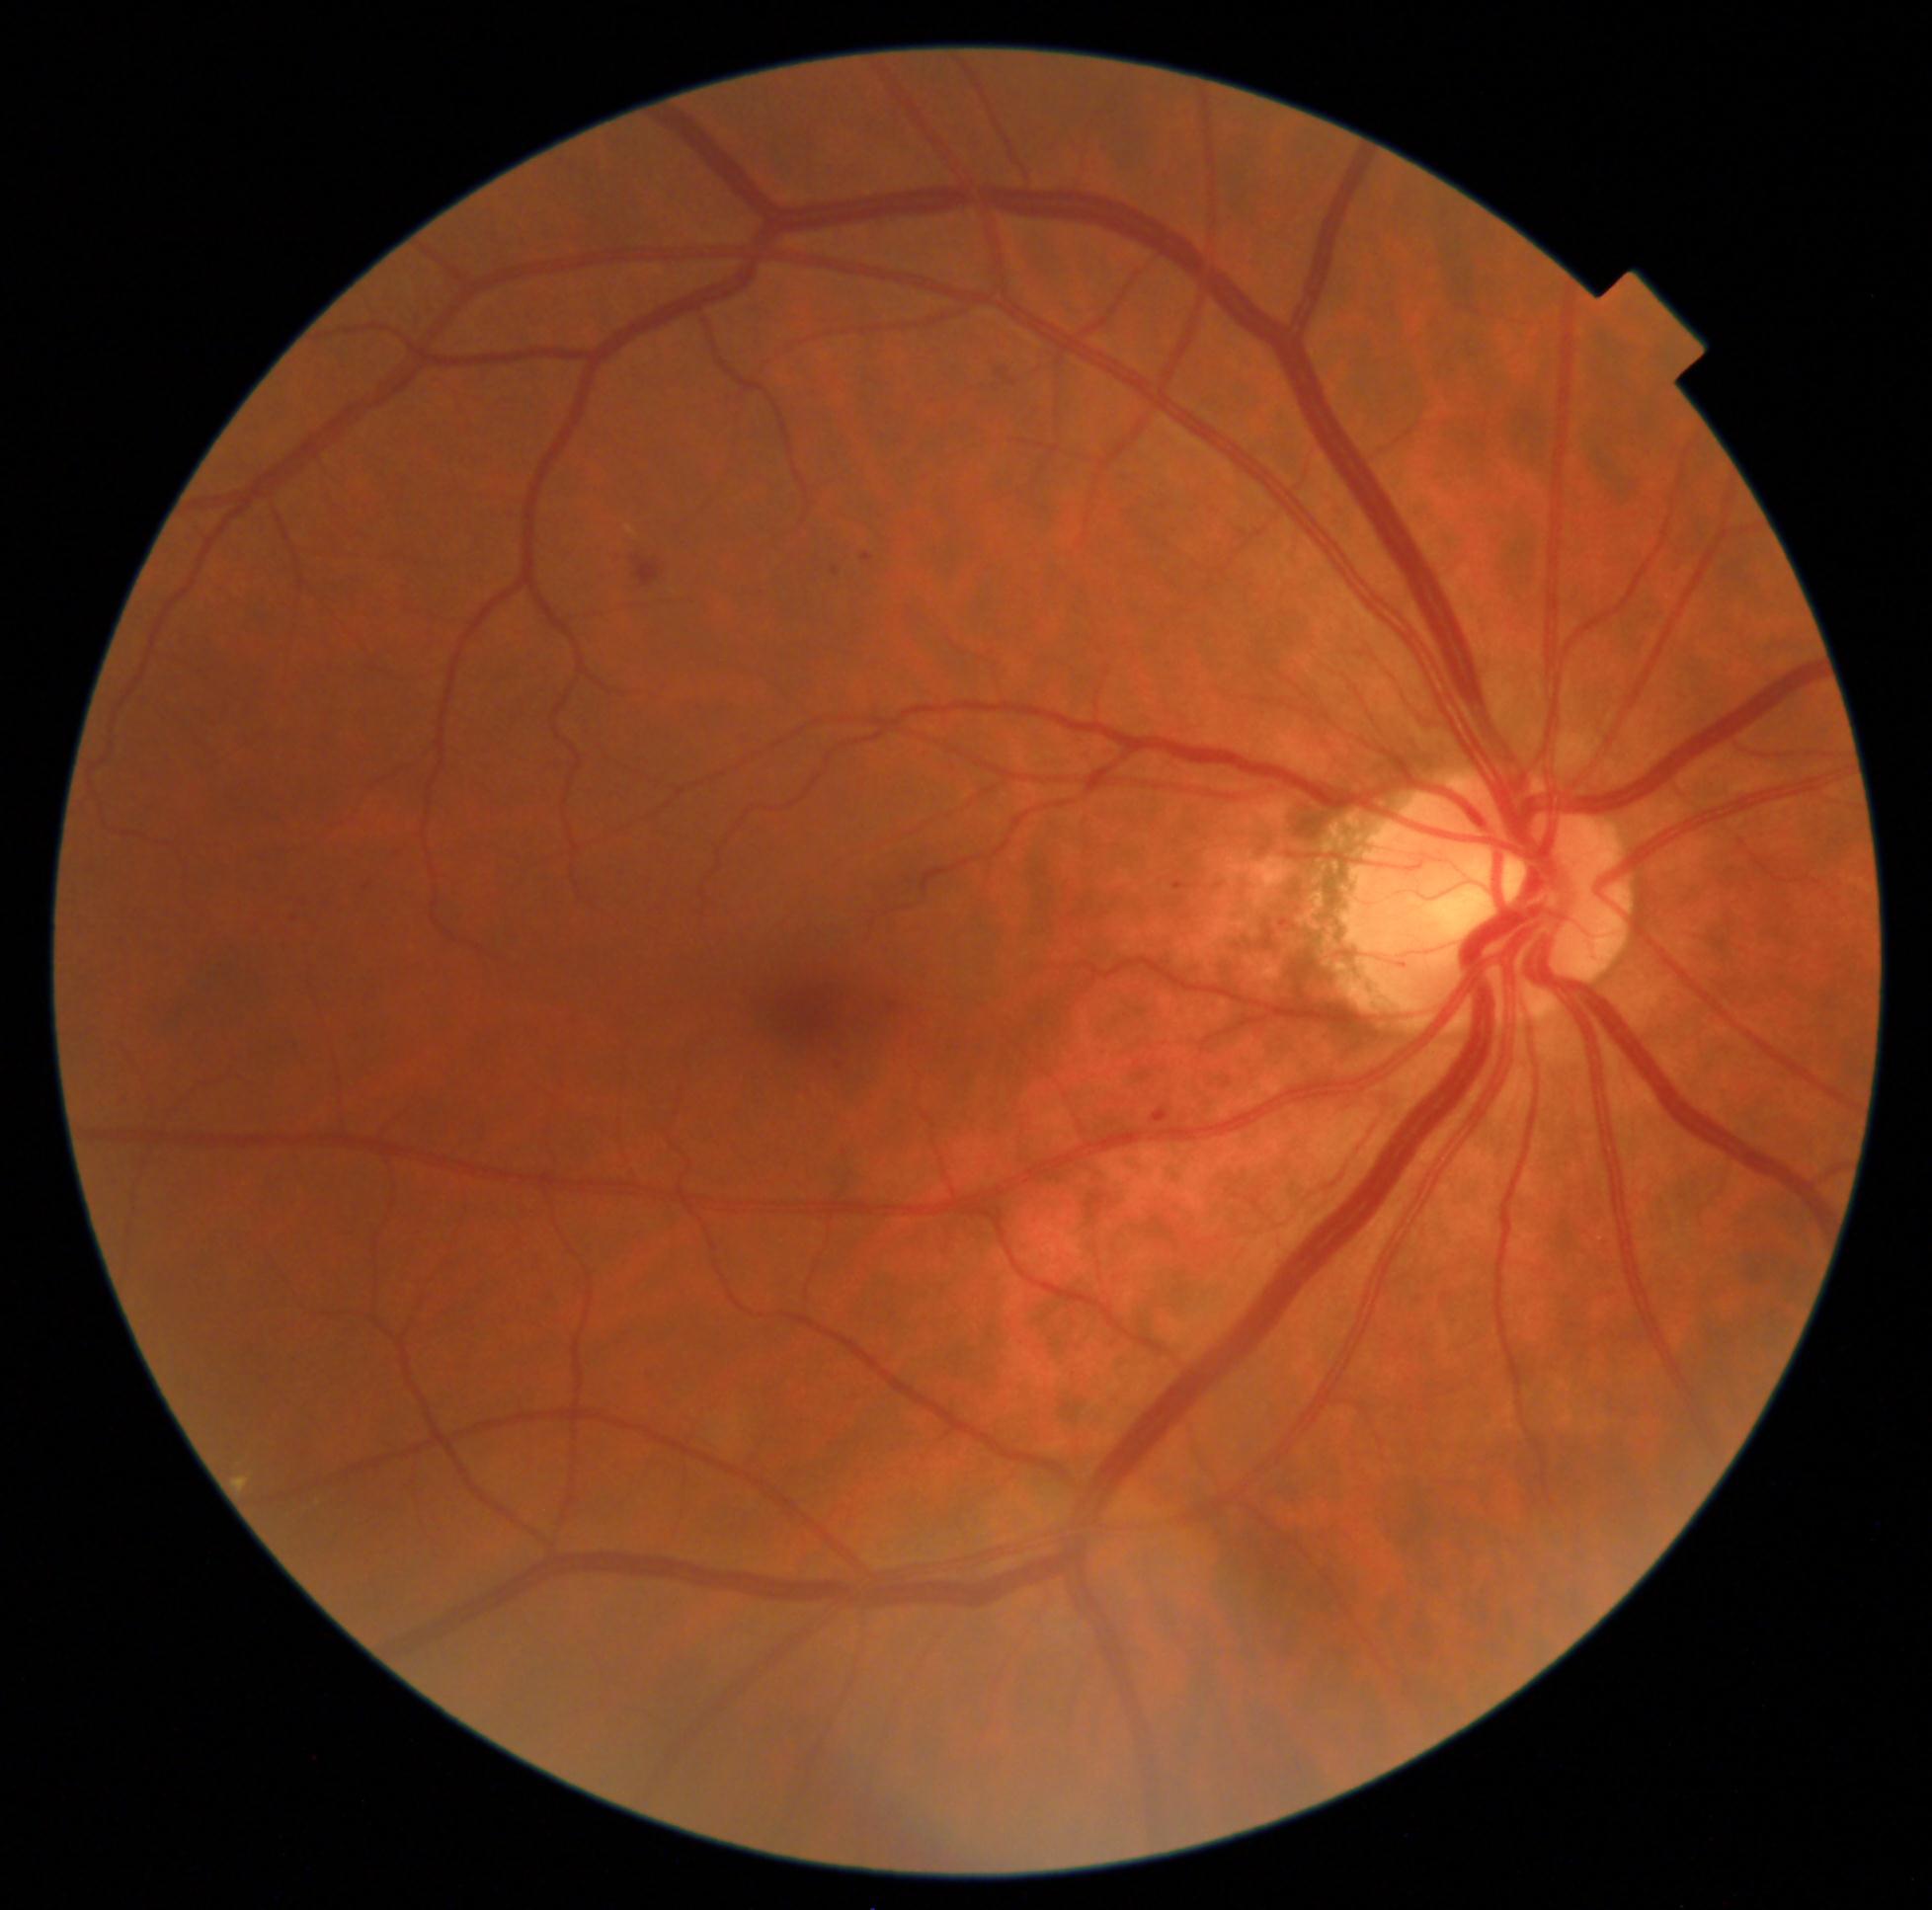 DR class: non-proliferative diabetic retinopathy; diabetic retinopathy (DR): grade 2 (moderate NPDR).